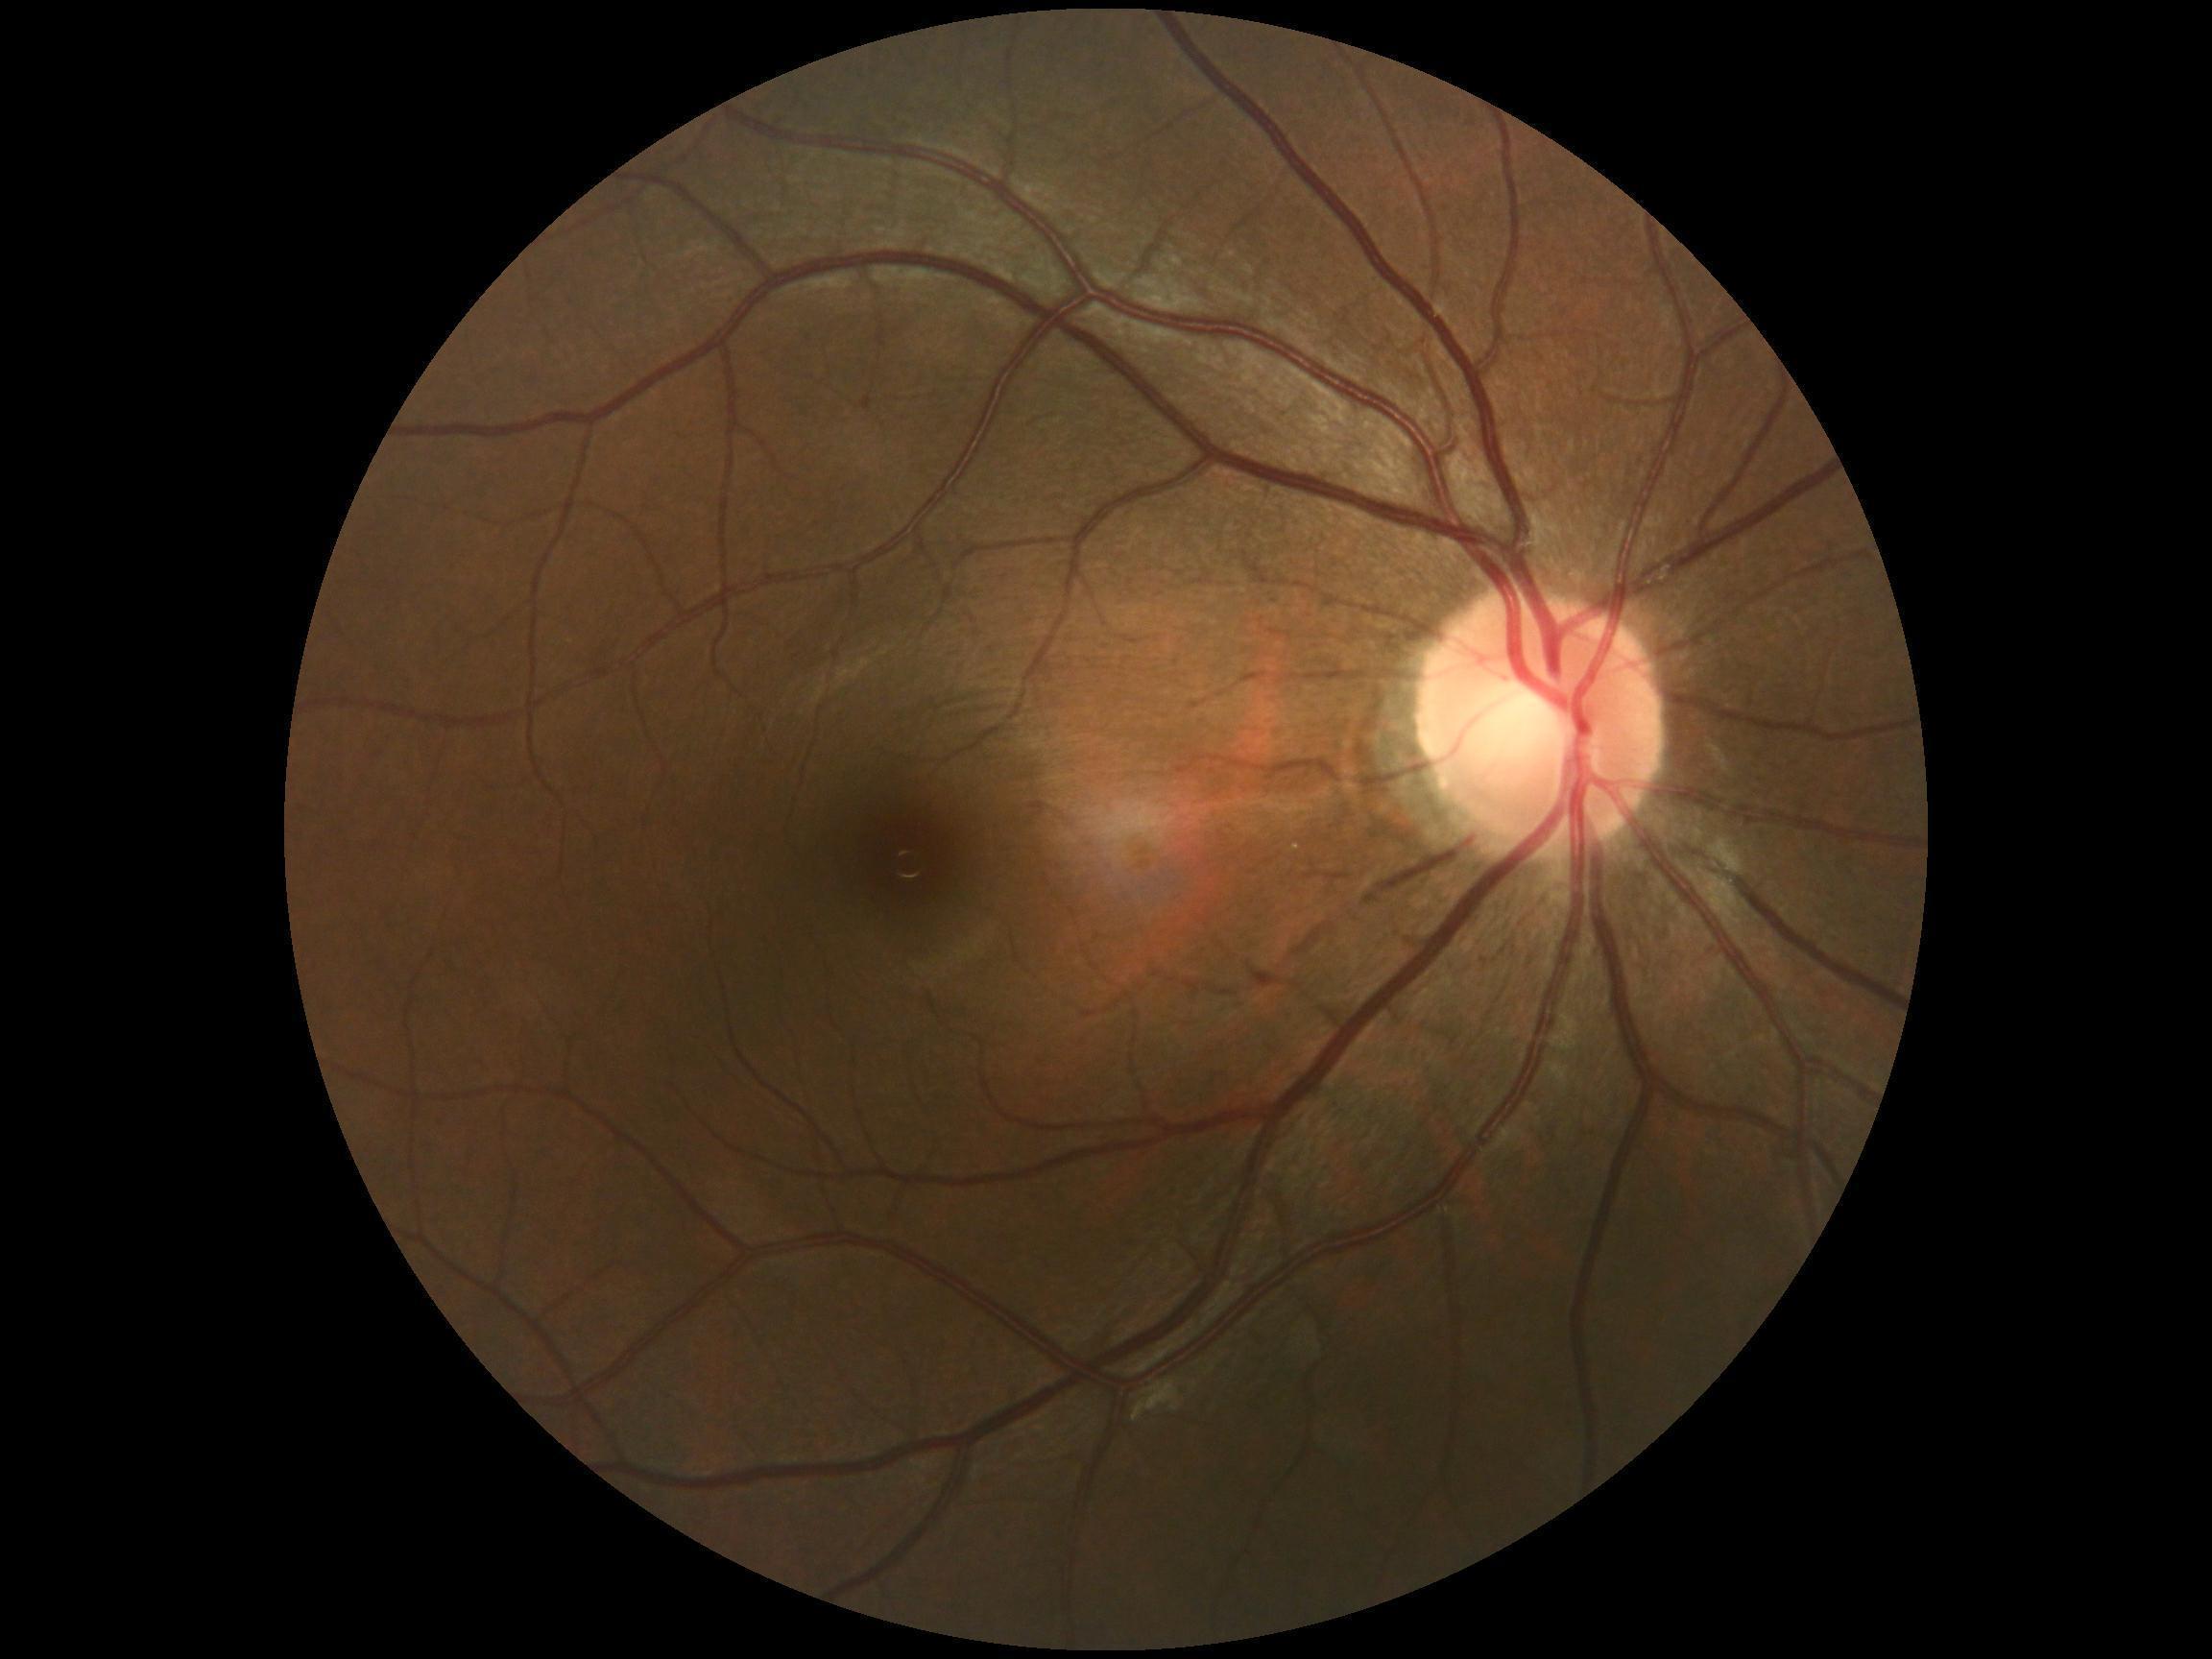 No signs of diabetic retinopathy. Diabetic retinopathy (DR) is no apparent retinopathy (grade 0).